Captured with the Phoenix ICON (100° field of view) · wide-field contact fundus photograph of an infant: 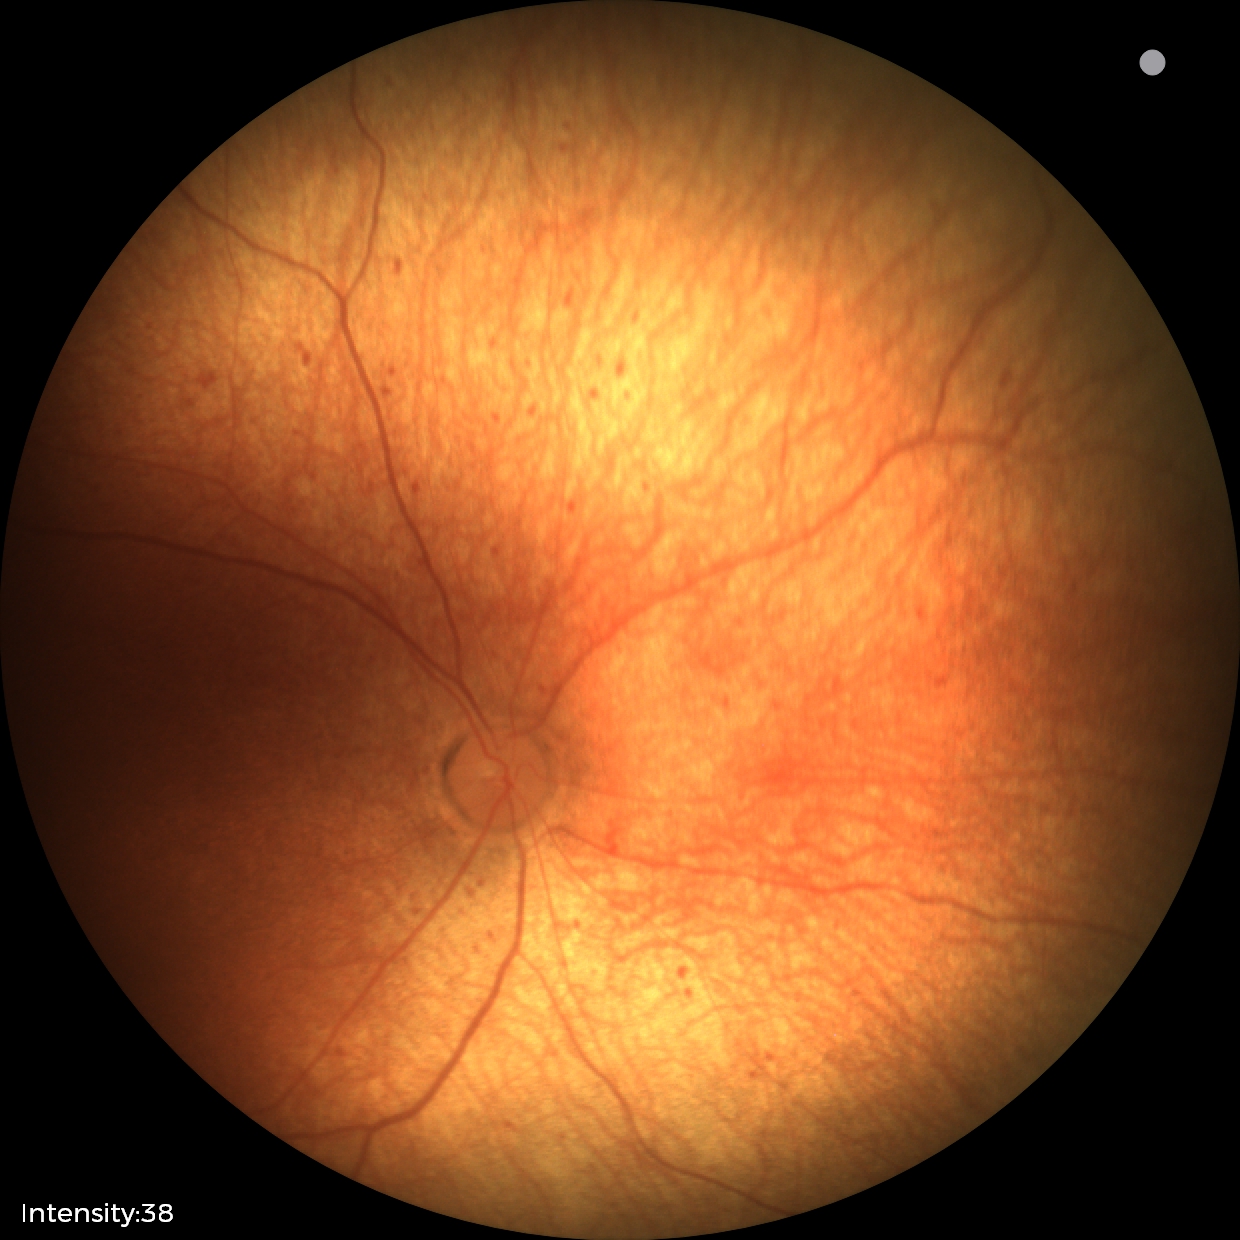
Q: Is plus disease present?
A: no plus disease
Q: What is the screening diagnosis?
A: status post retinopathy of prematurity